Captured with the Phoenix ICON (100° field of view) · wide-field fundus photograph from neonatal ROP screening · 1240 x 1240 pixels
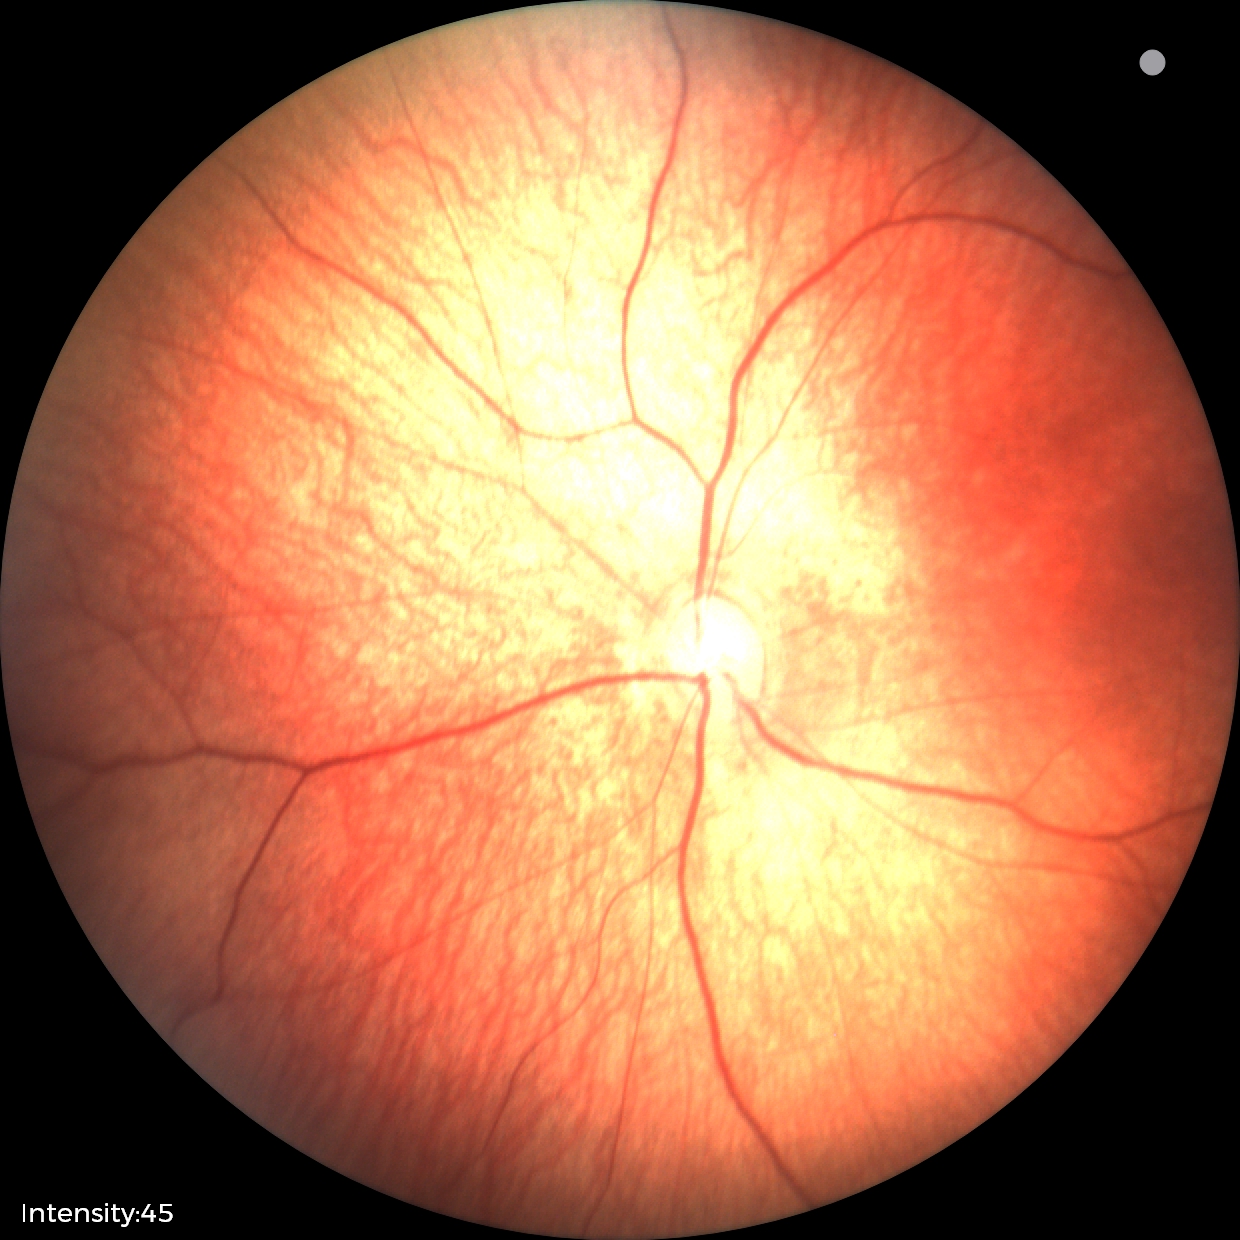
Assessment: no abnormal retinal findings.